Optic disc-centered crop from a color fundus photograph.
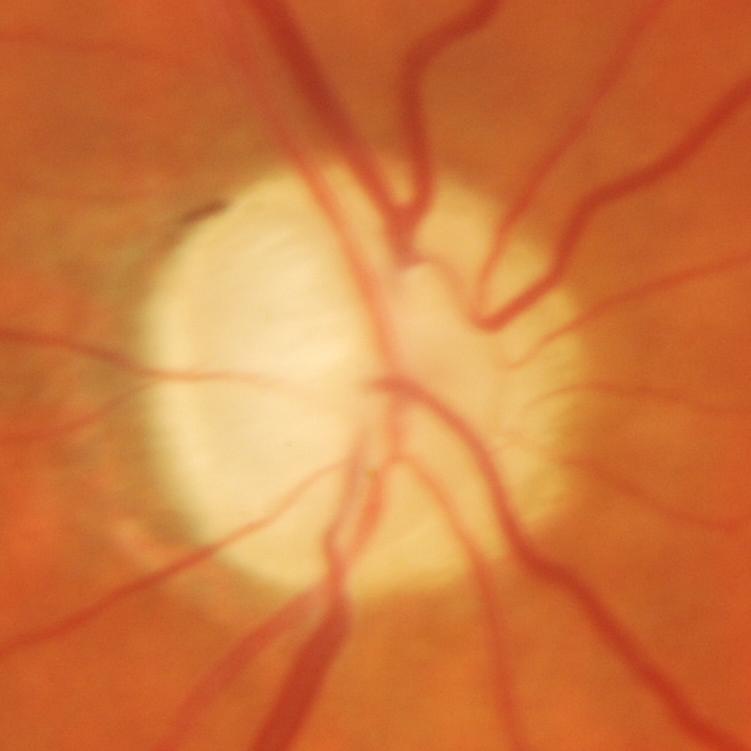

Glaucomatous changes are present. Diagnosis = glaucomatous findings.